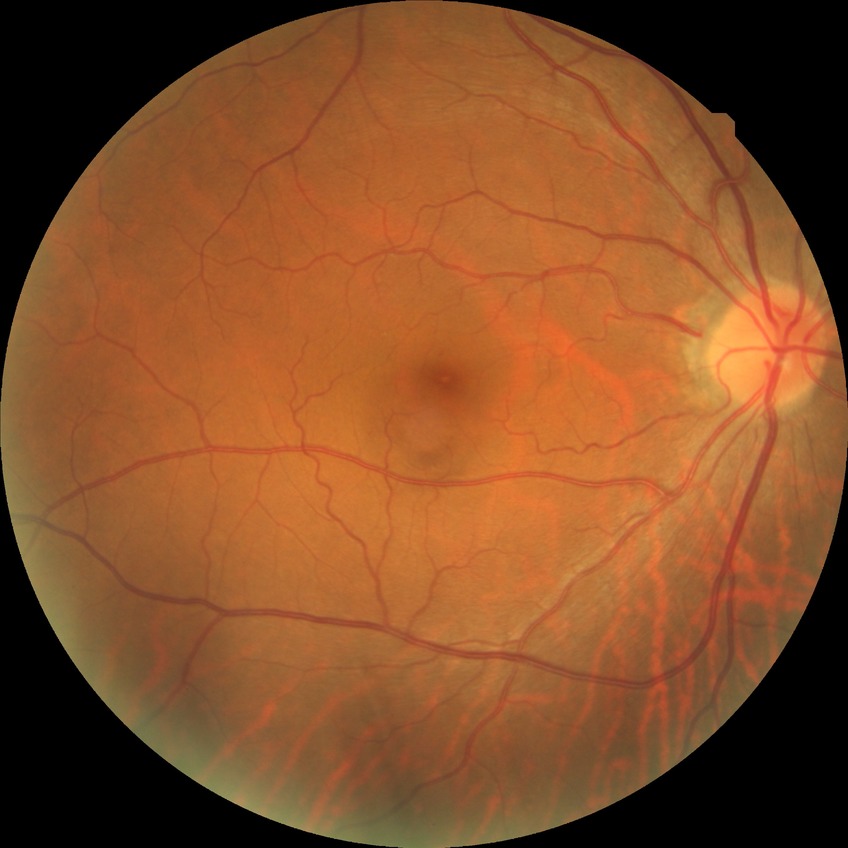 Diabetic retinopathy (DR): no diabetic retinopathy (NDR).